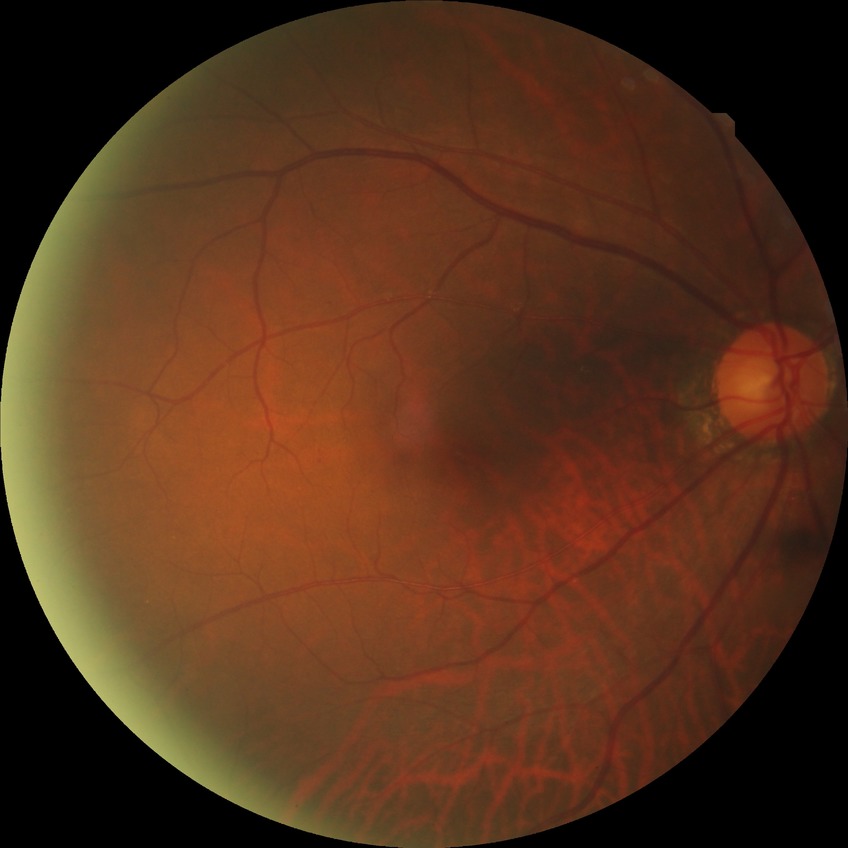
Modified Davis classification: no diabetic retinopathy.